2048x1536; color fundus photograph — 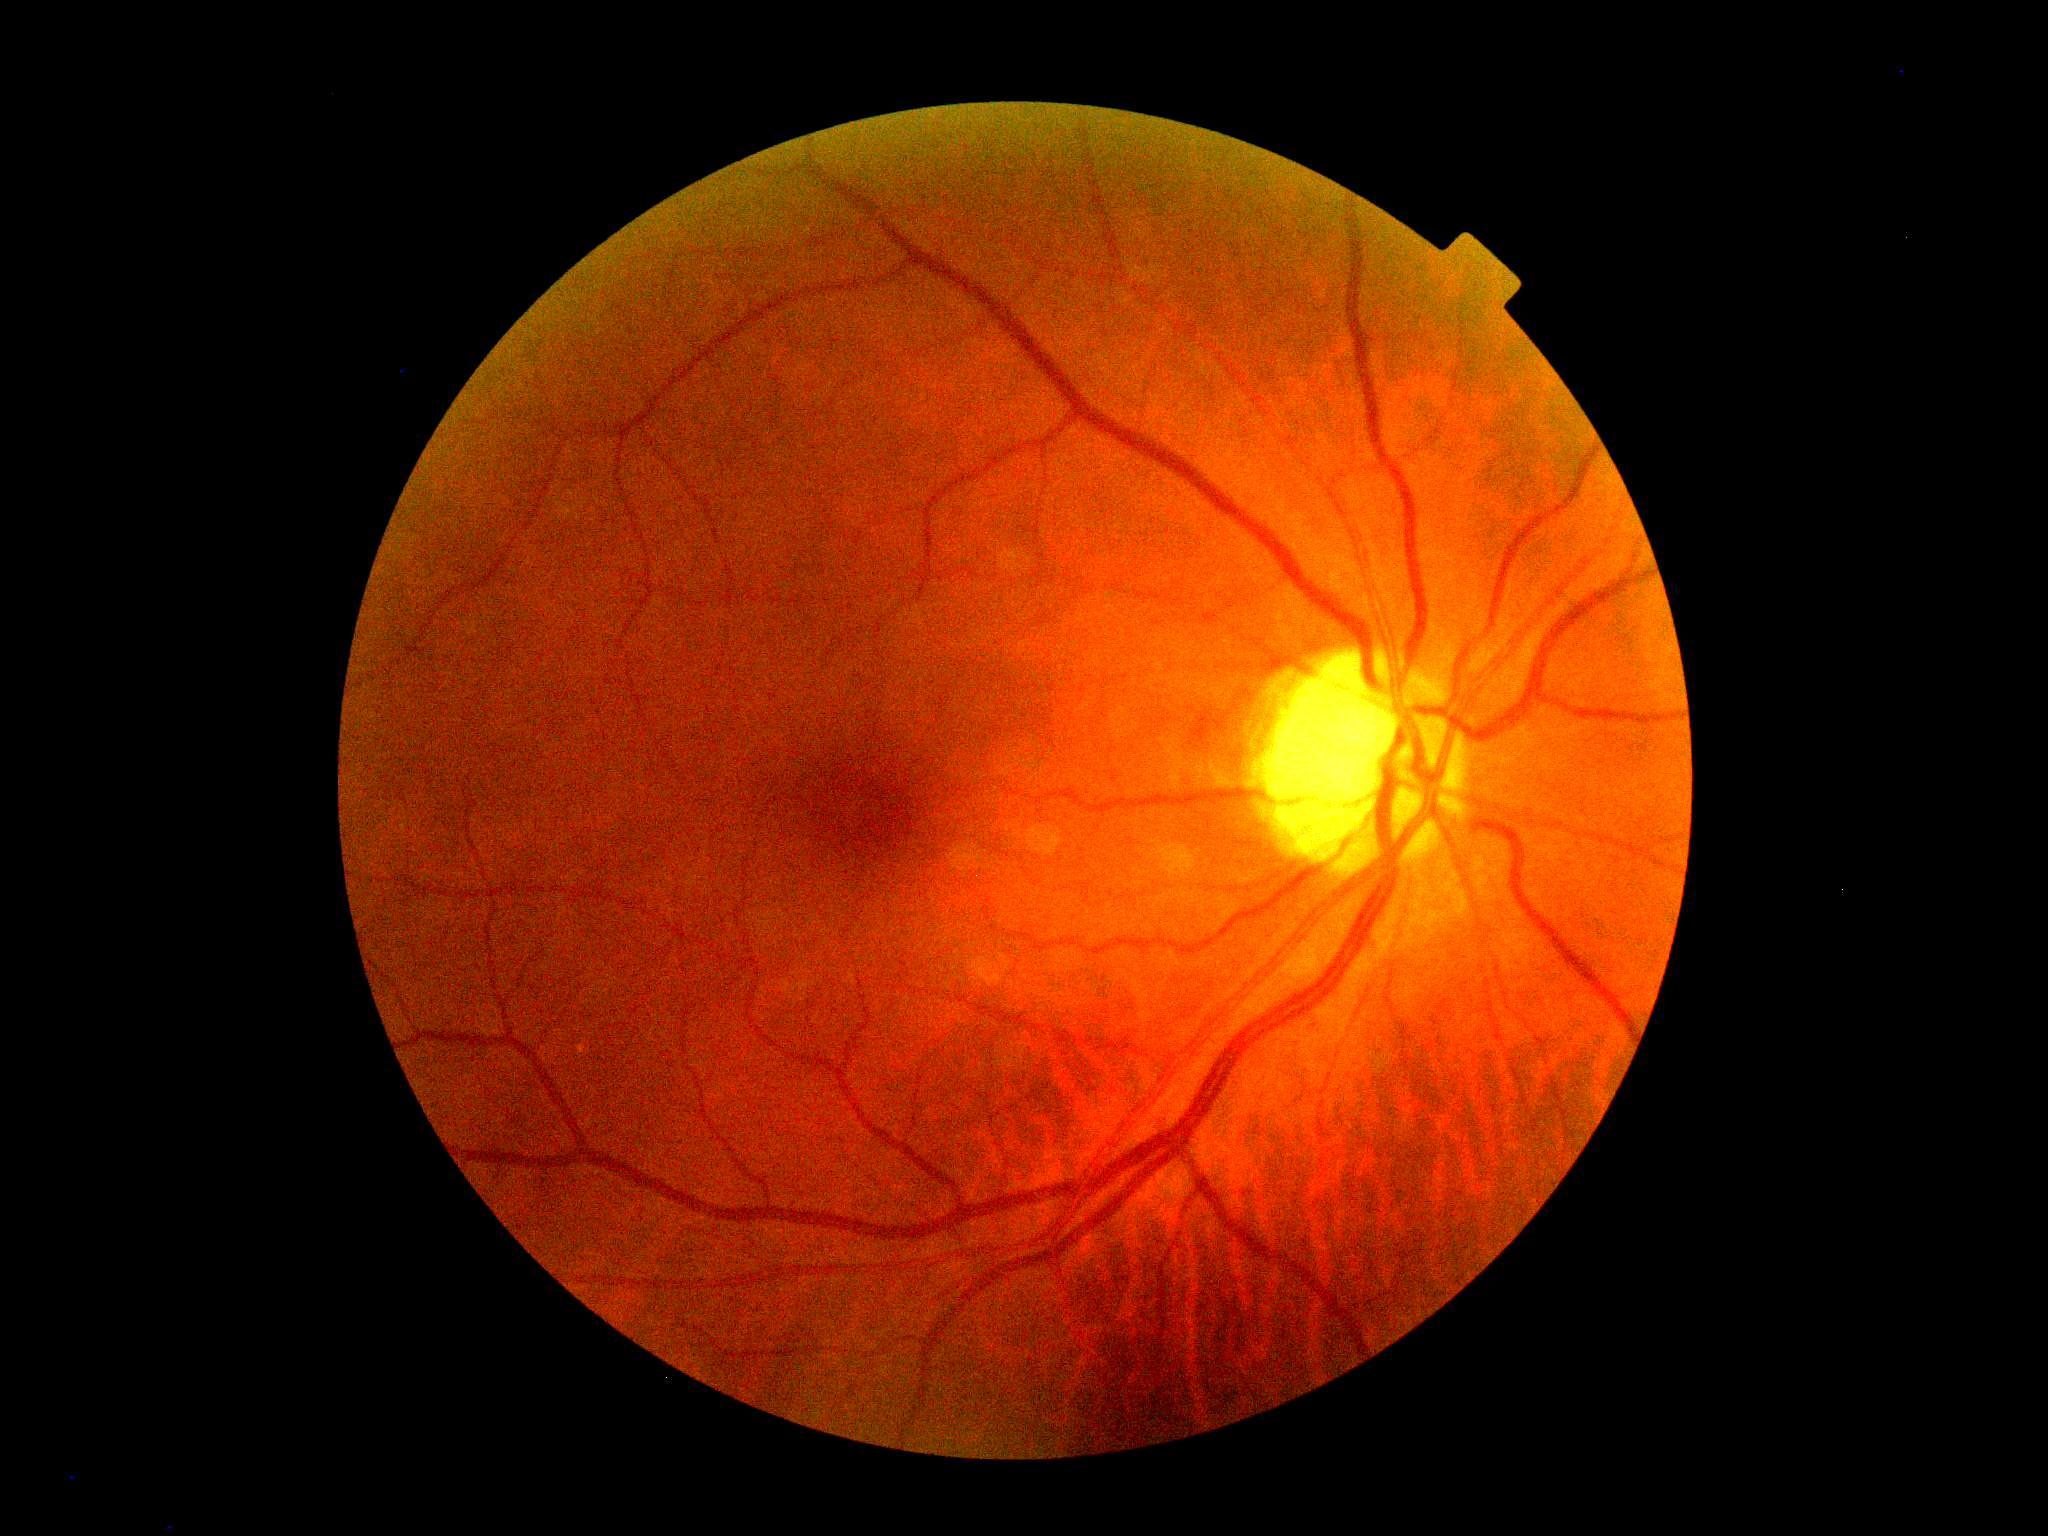
diabetic retinopathy = grade 0 (no apparent retinopathy).